45-degree field of view — 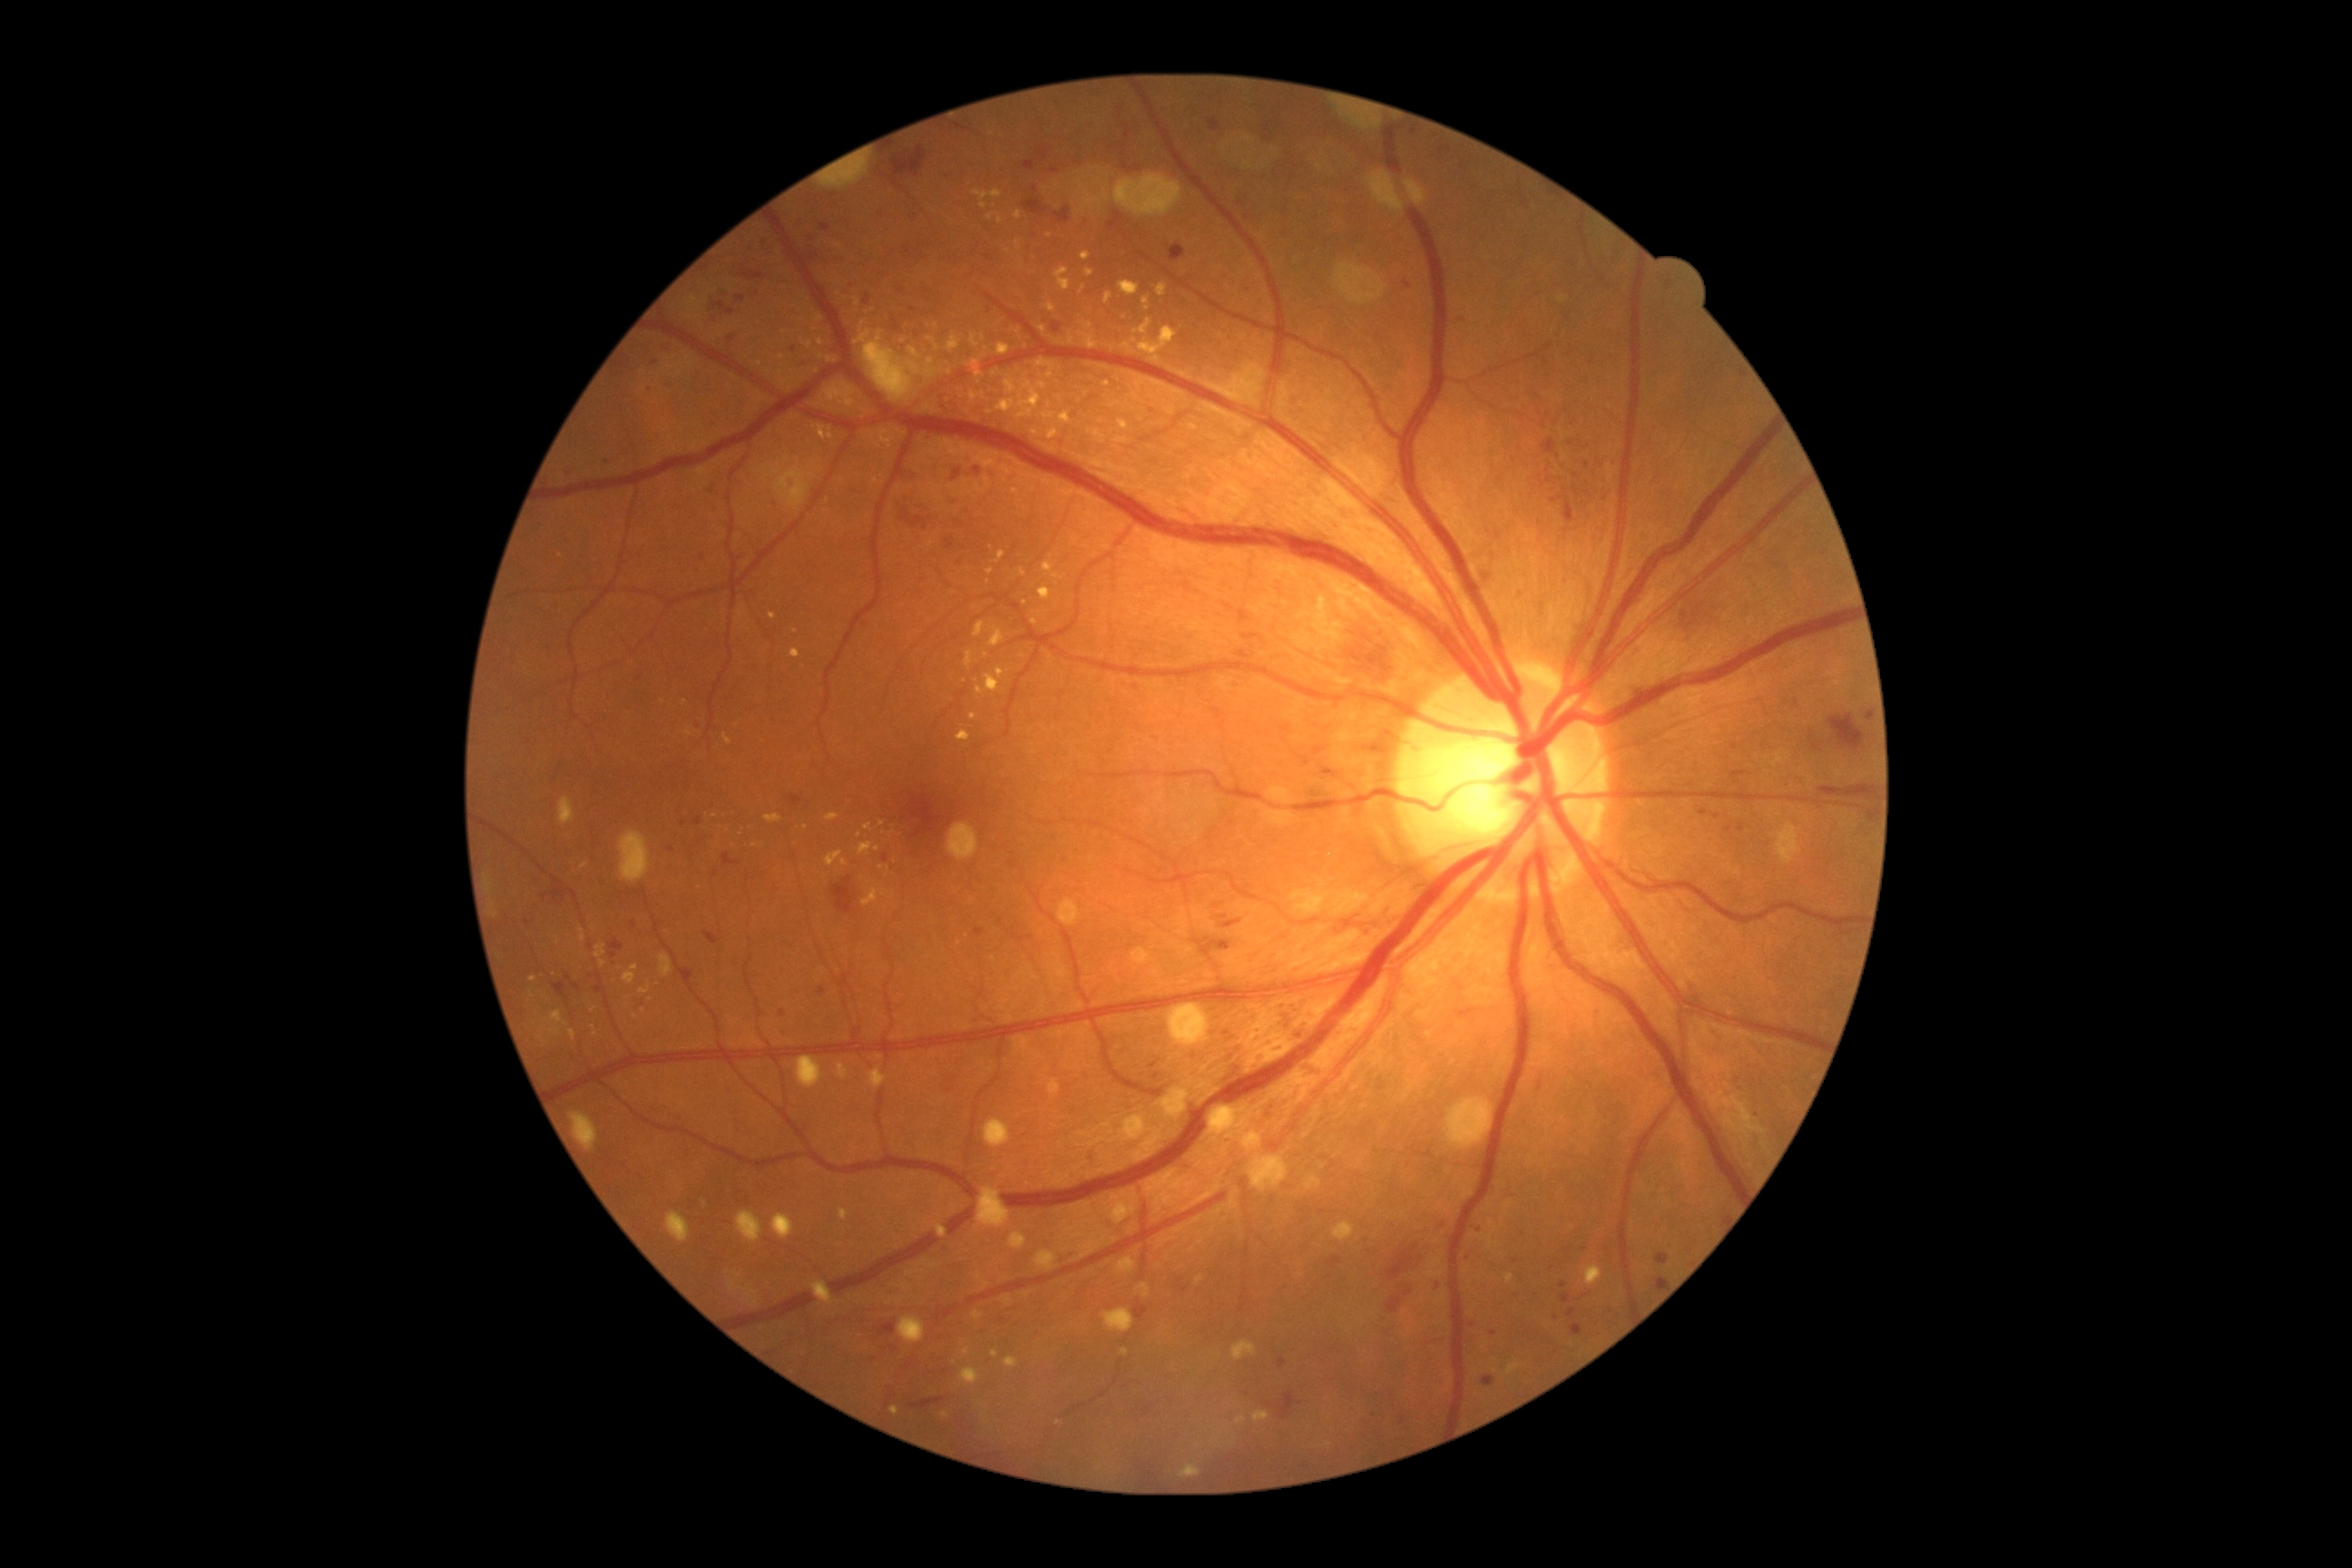

  dr_grade: 2/4